Graded on the modified Davis scale: 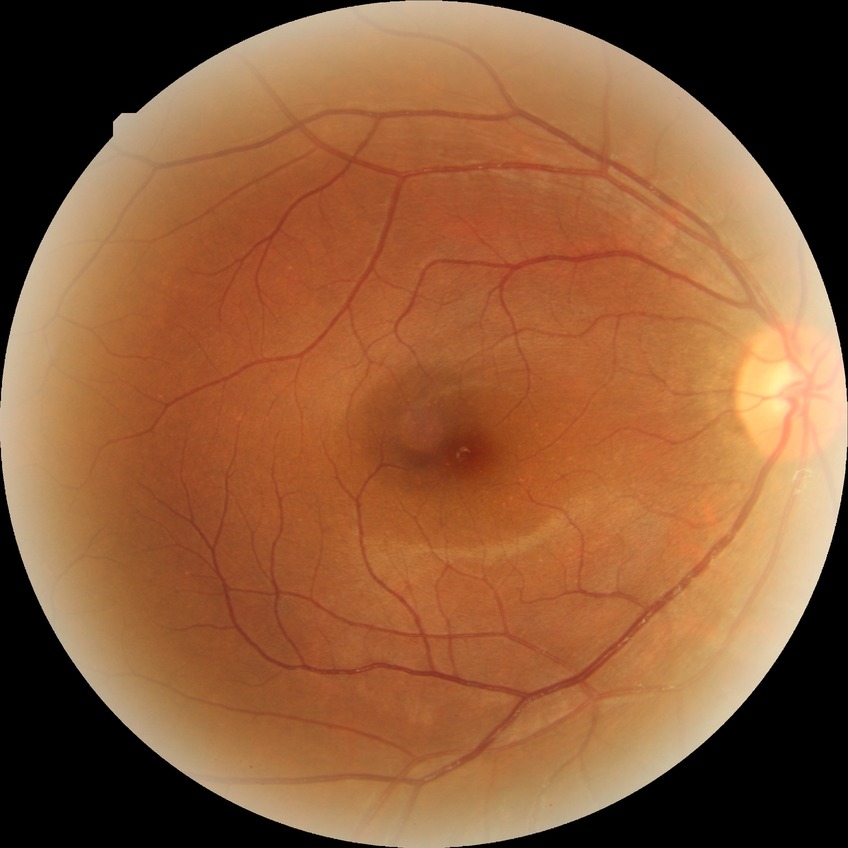

diabetic retinopathy (DR)=NDR (no diabetic retinopathy).